Fundus photo
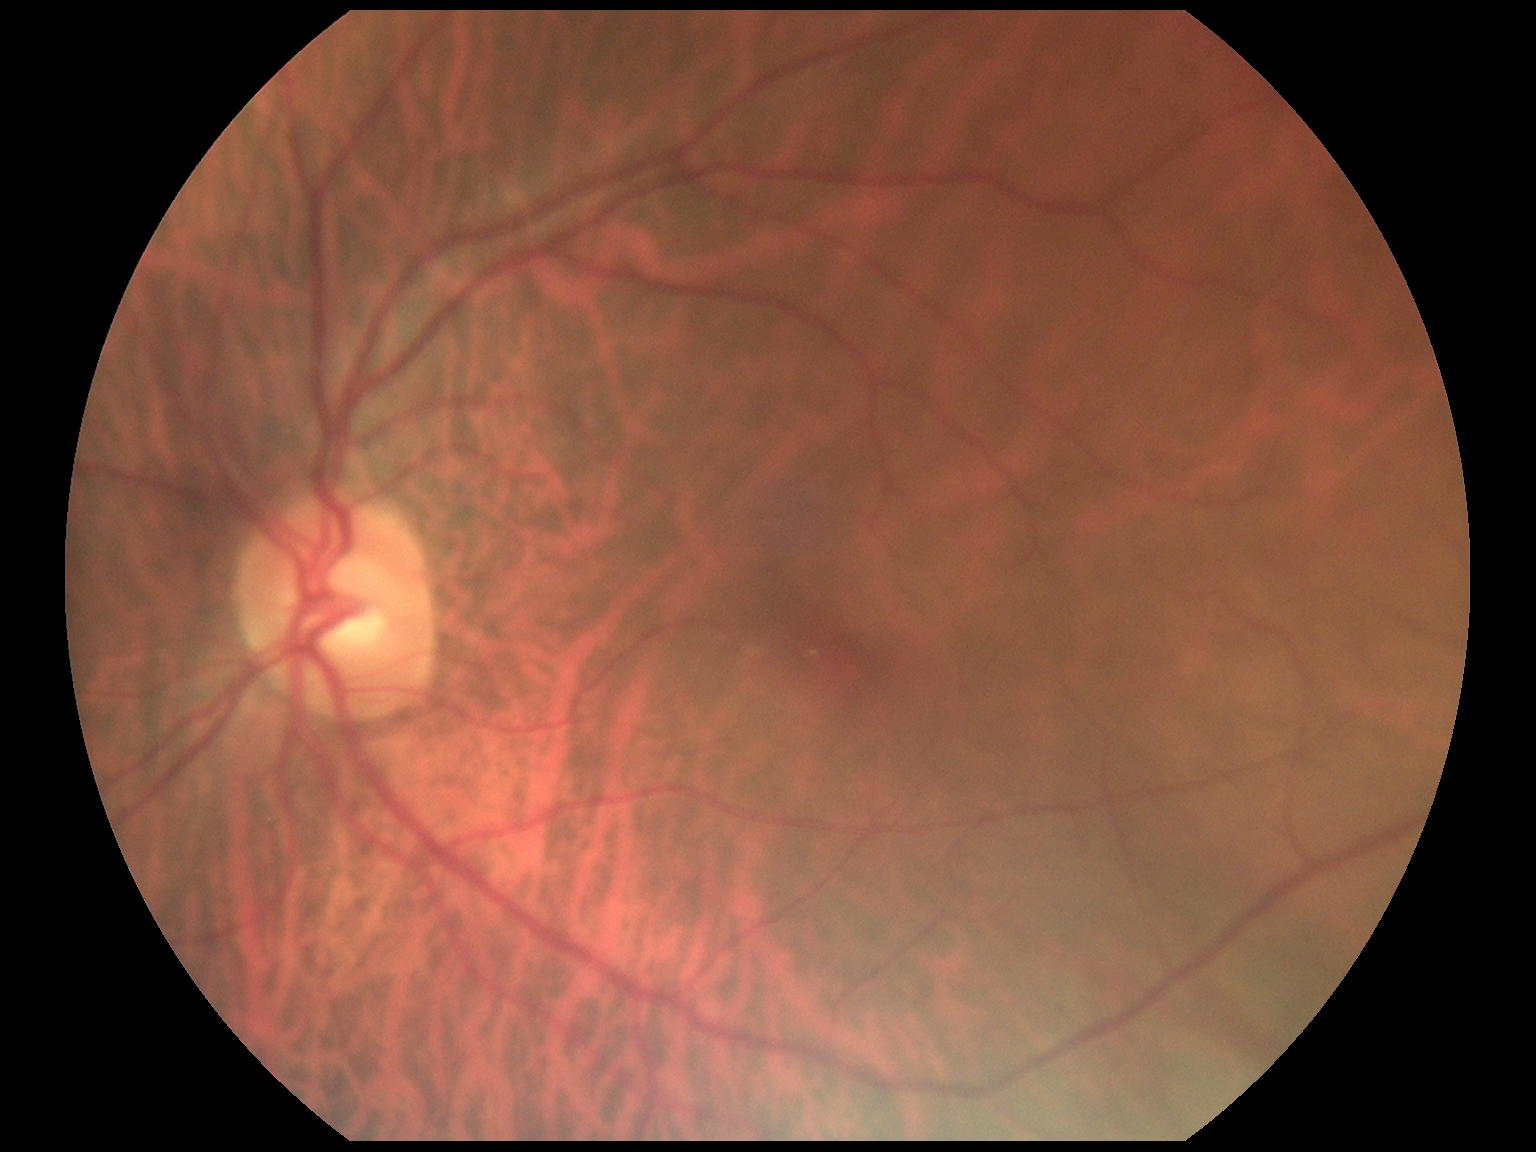 Diabetic retinopathy is 0/4.